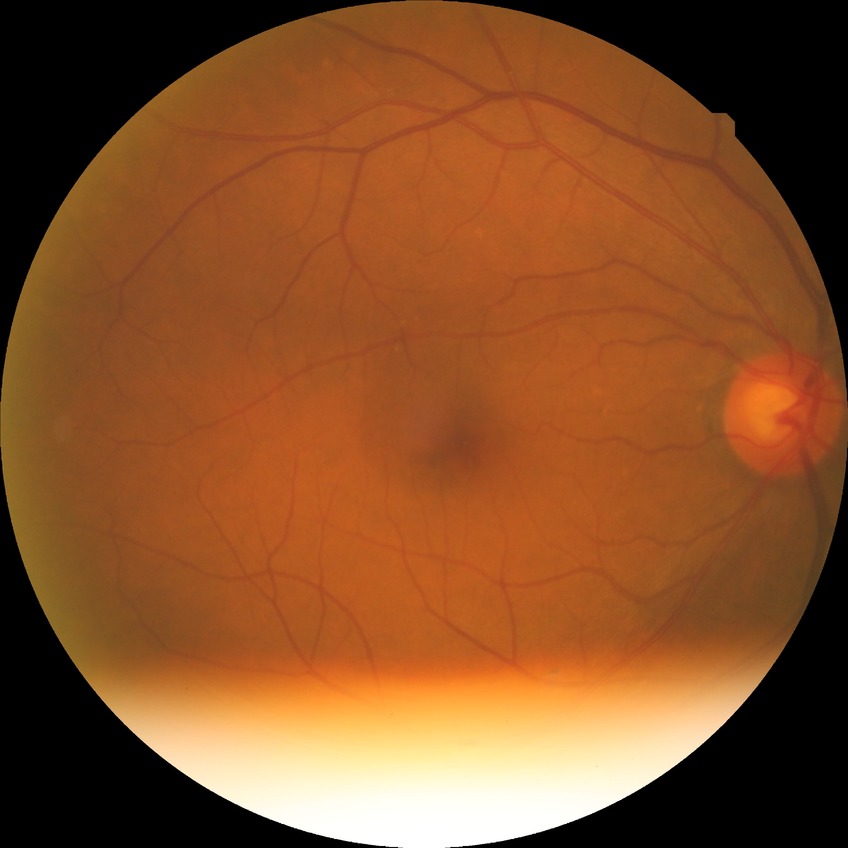

Davis grade = NDR | DR impression = no apparent DR.